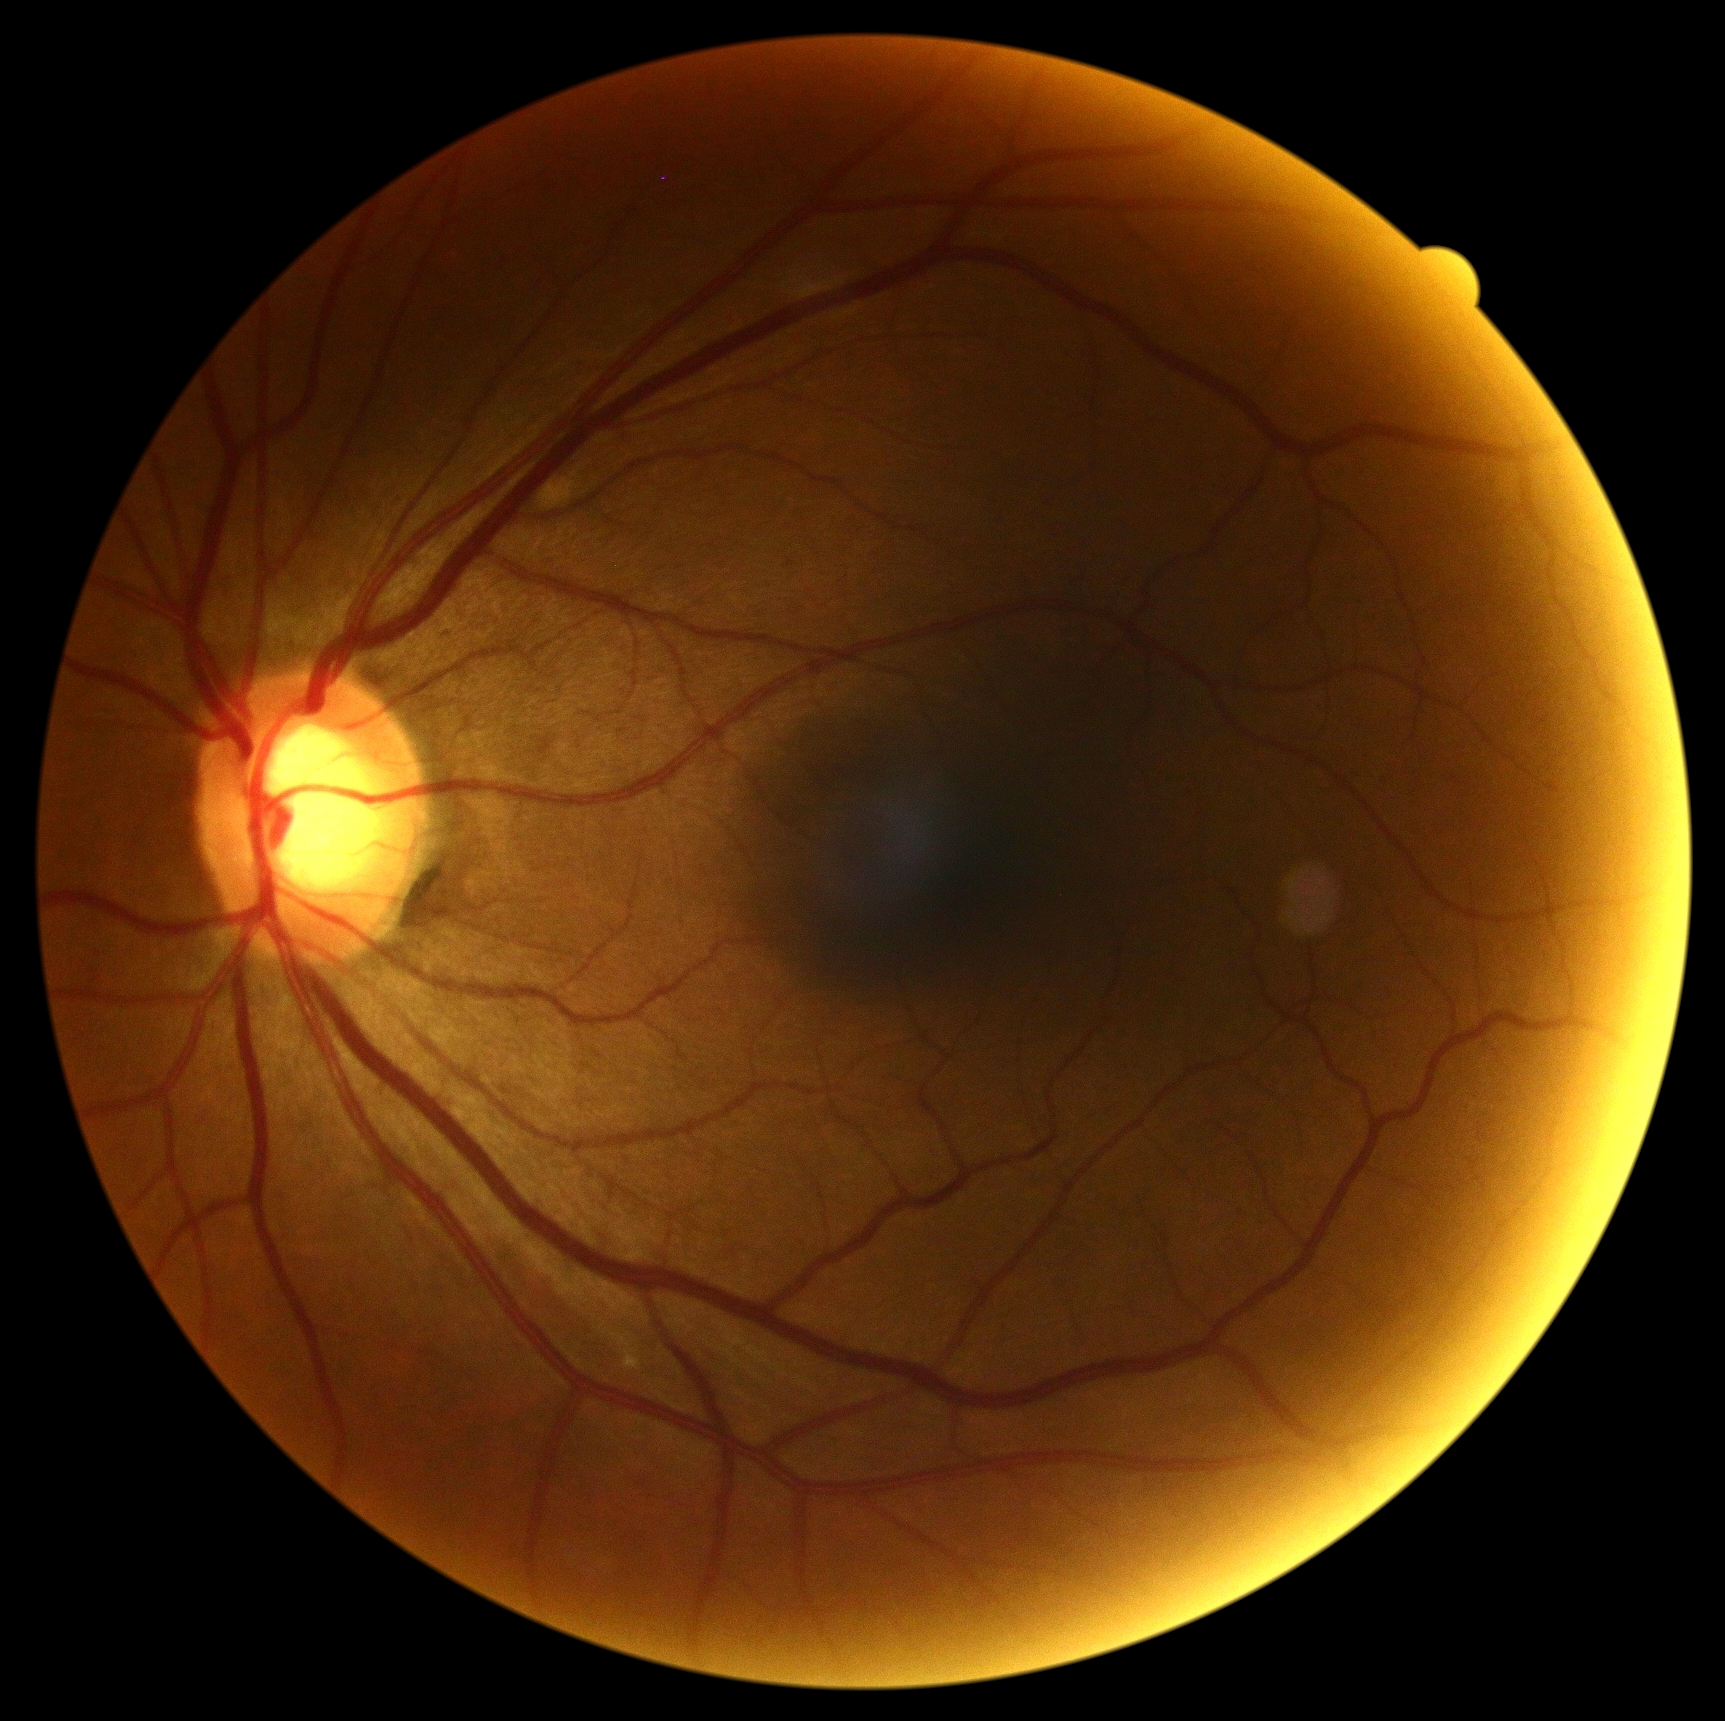

No apparent diabetic retinopathy. Diabetic retinopathy (DR): grade 0.